Retinal fundus photograph — 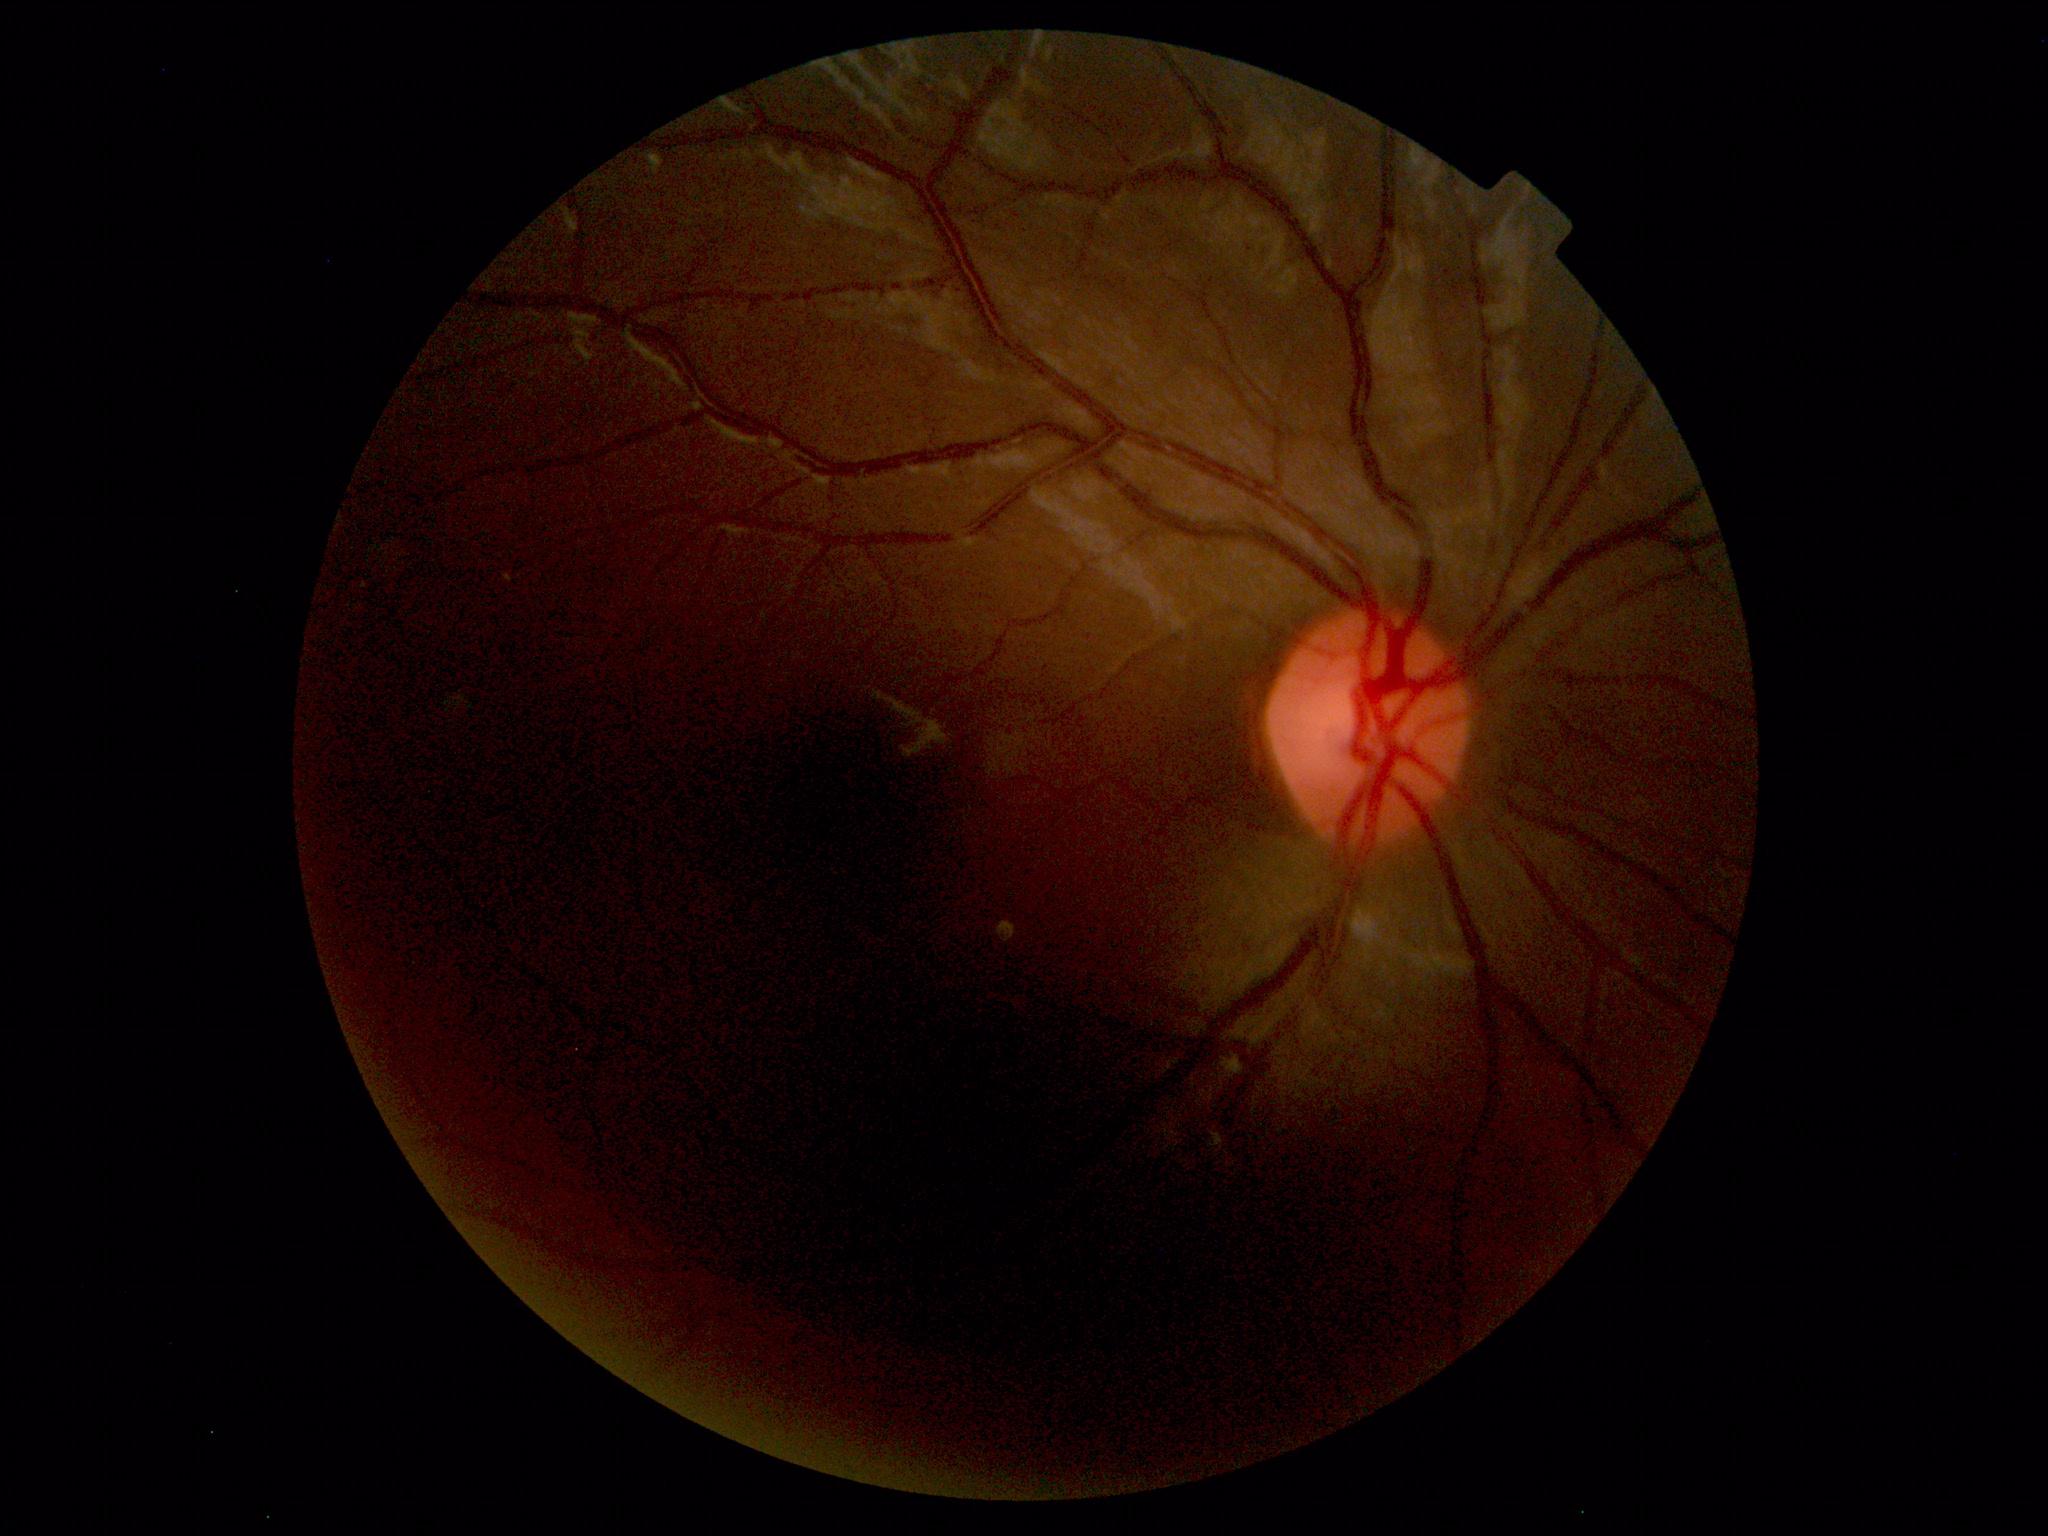

Within normal limits. No abnormalities identified.